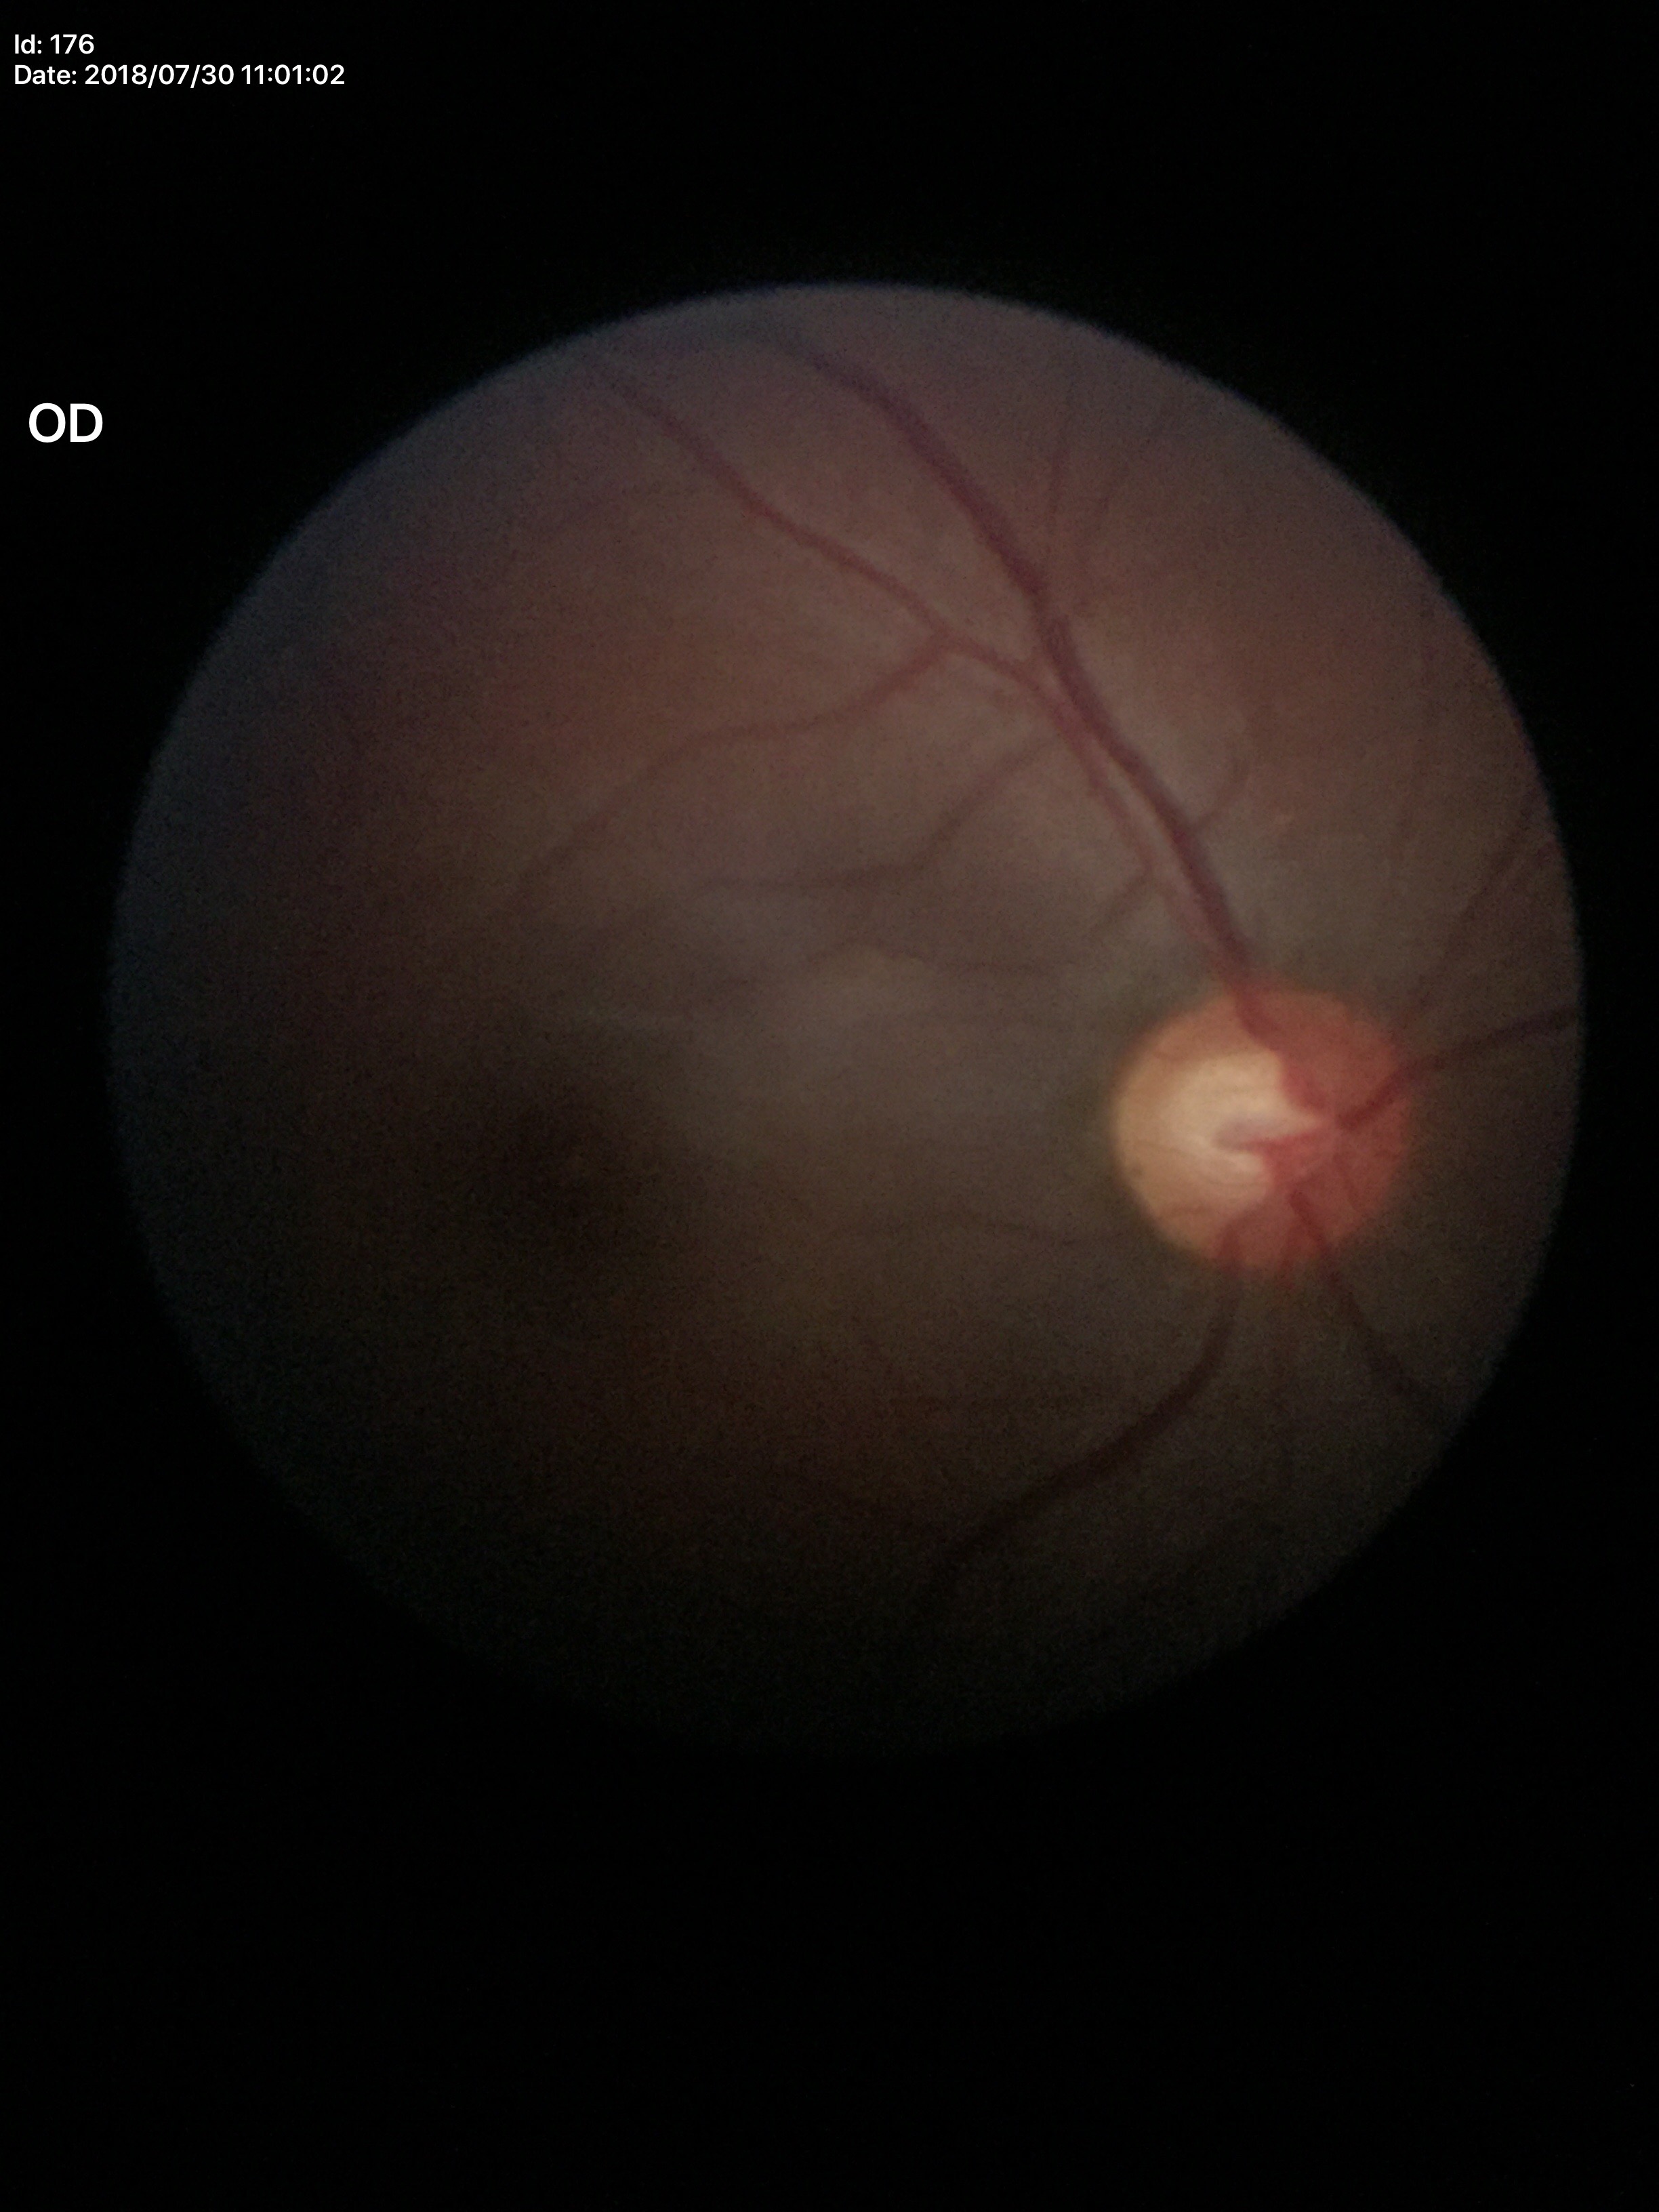

Glaucoma assessment: suspicious findings.
Vertical cup-disc ratio: 0.67.
Area cup-disc ratio is 0.41.